45-degree field of view; 2048 by 1536 pixels; retinal fundus photograph — 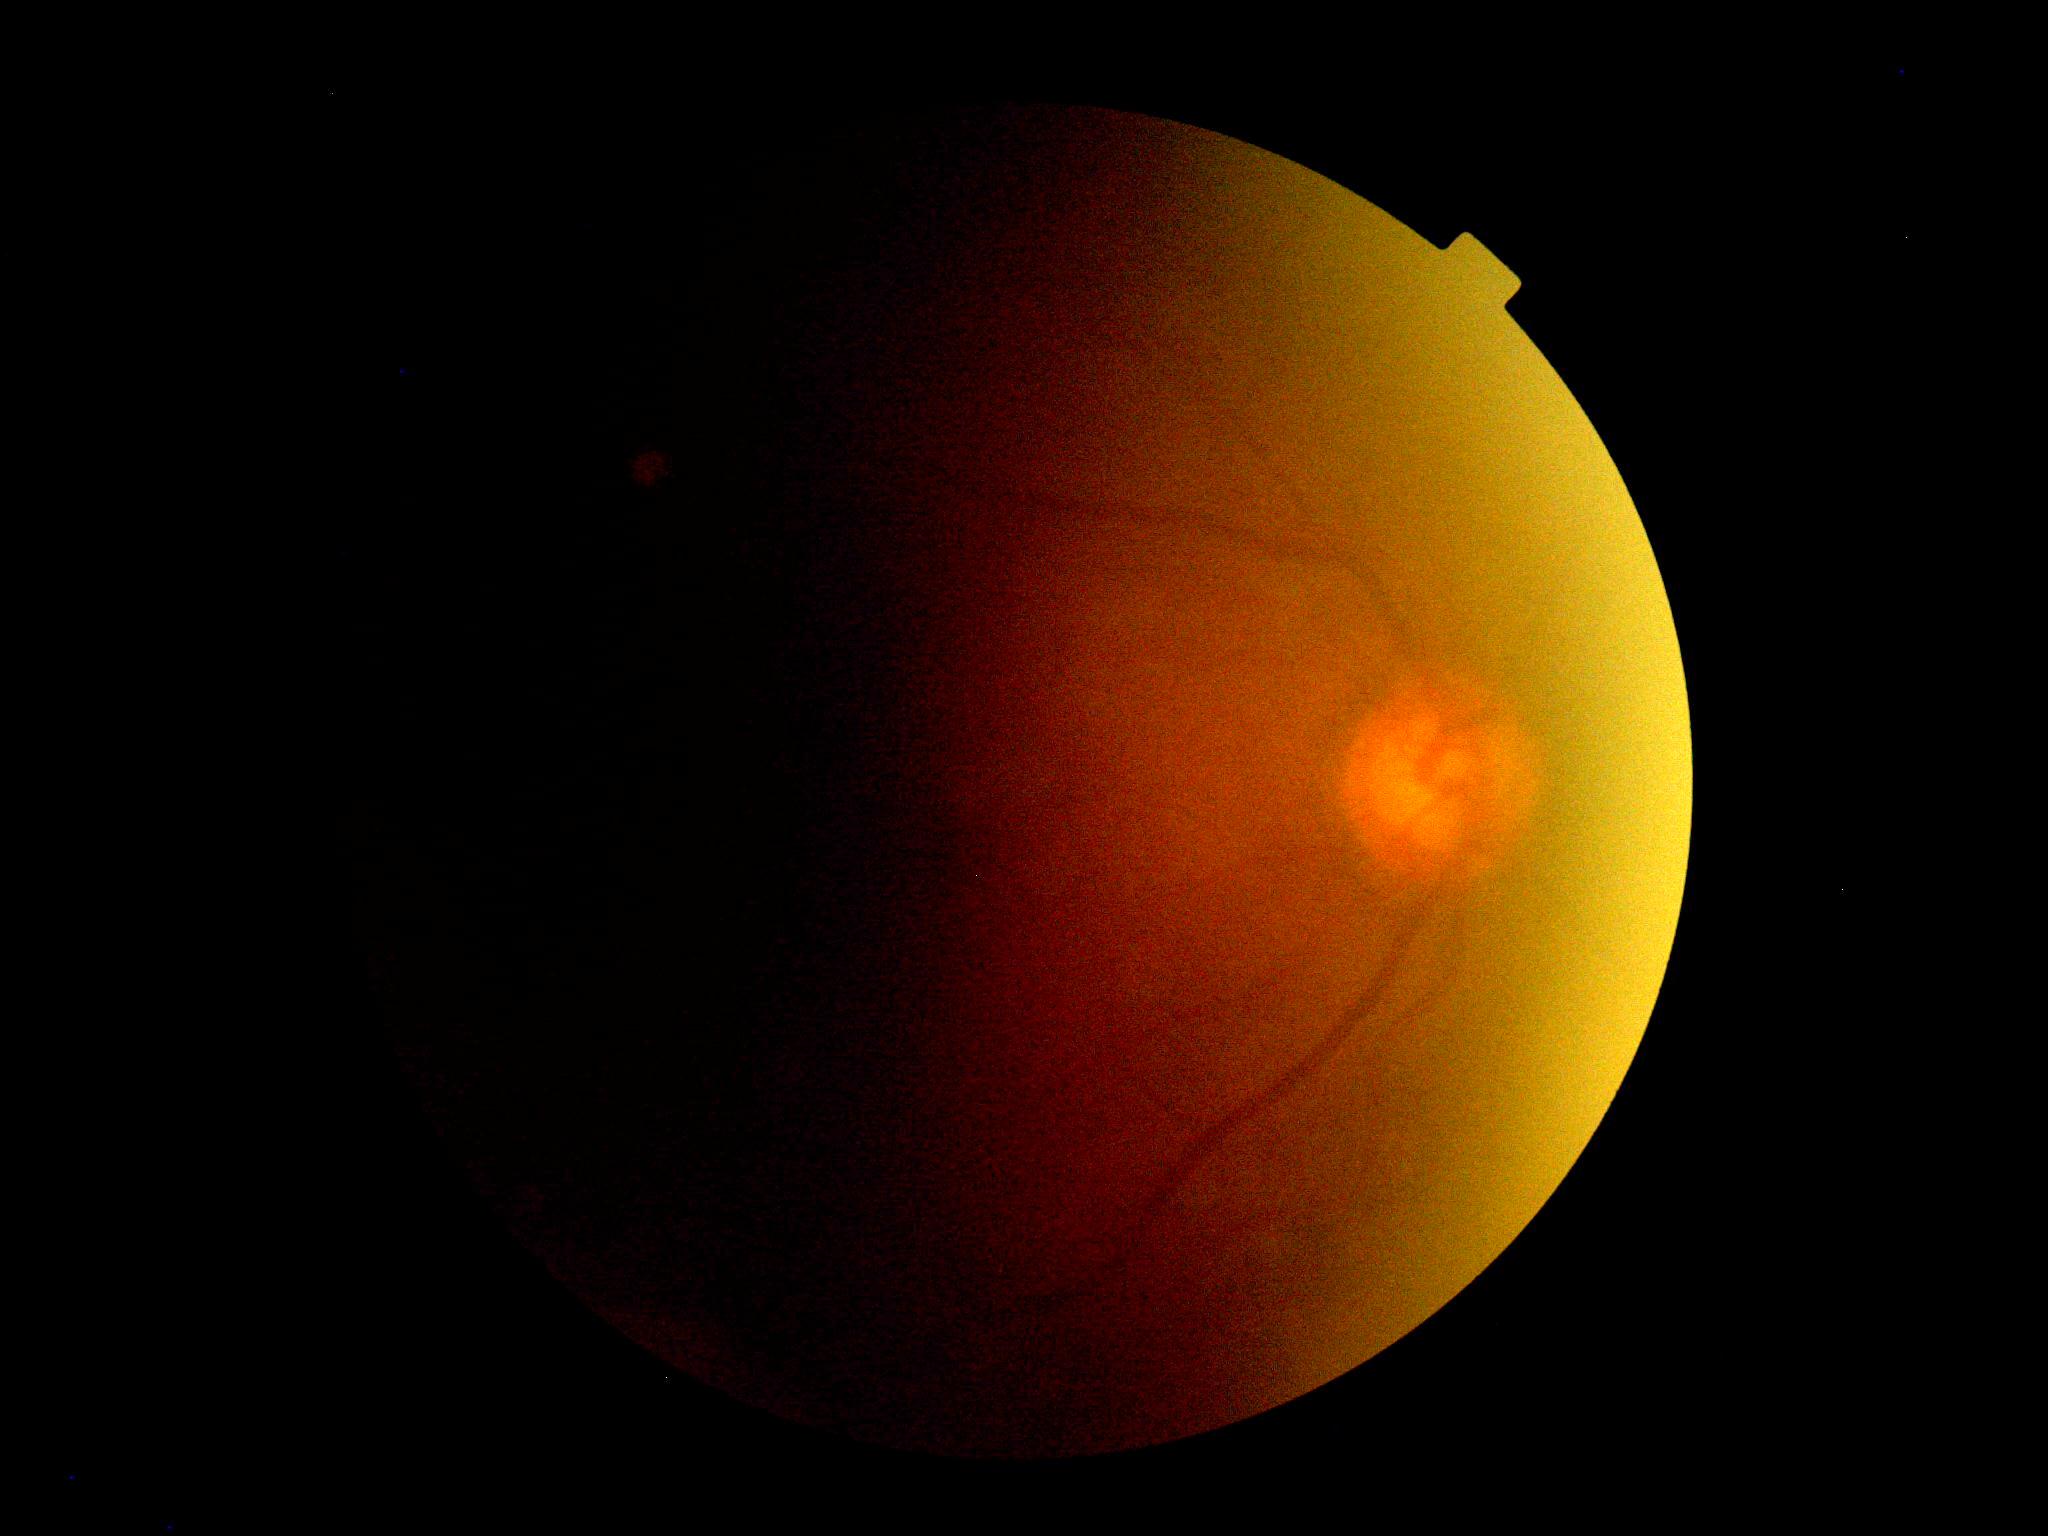 Findings:
- image quality — below grading threshold
- diabetic retinopathy (DR) — ungradable due to poor image quality